Wide-field contact fundus photograph of an infant.
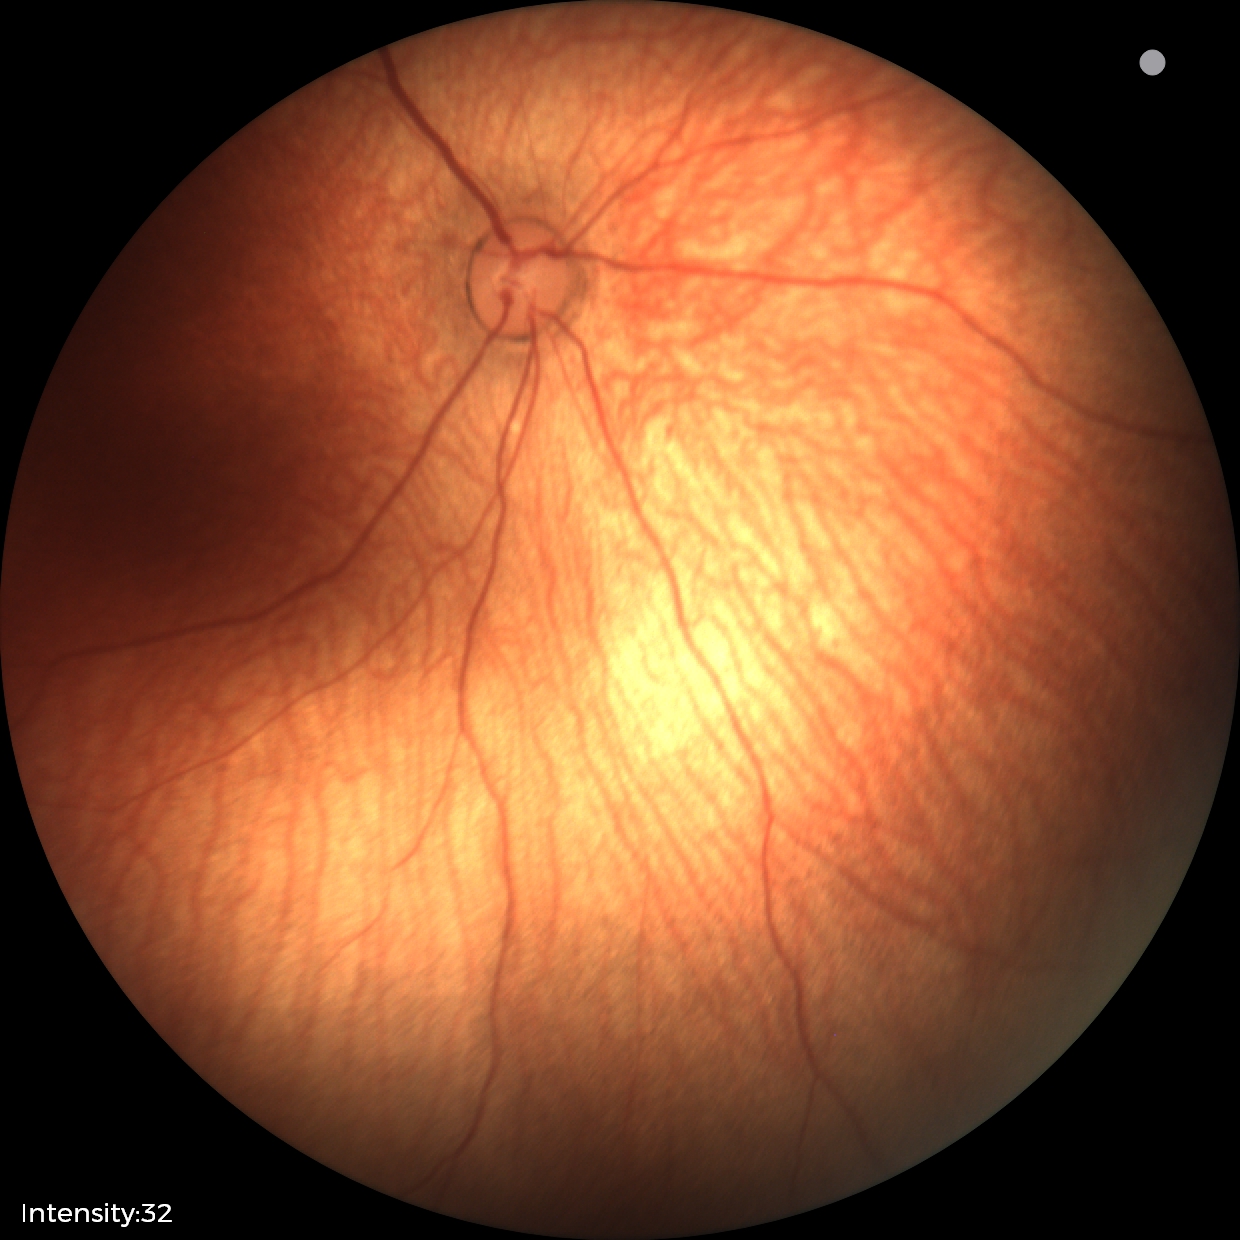 No retinal pathology identified on screening.